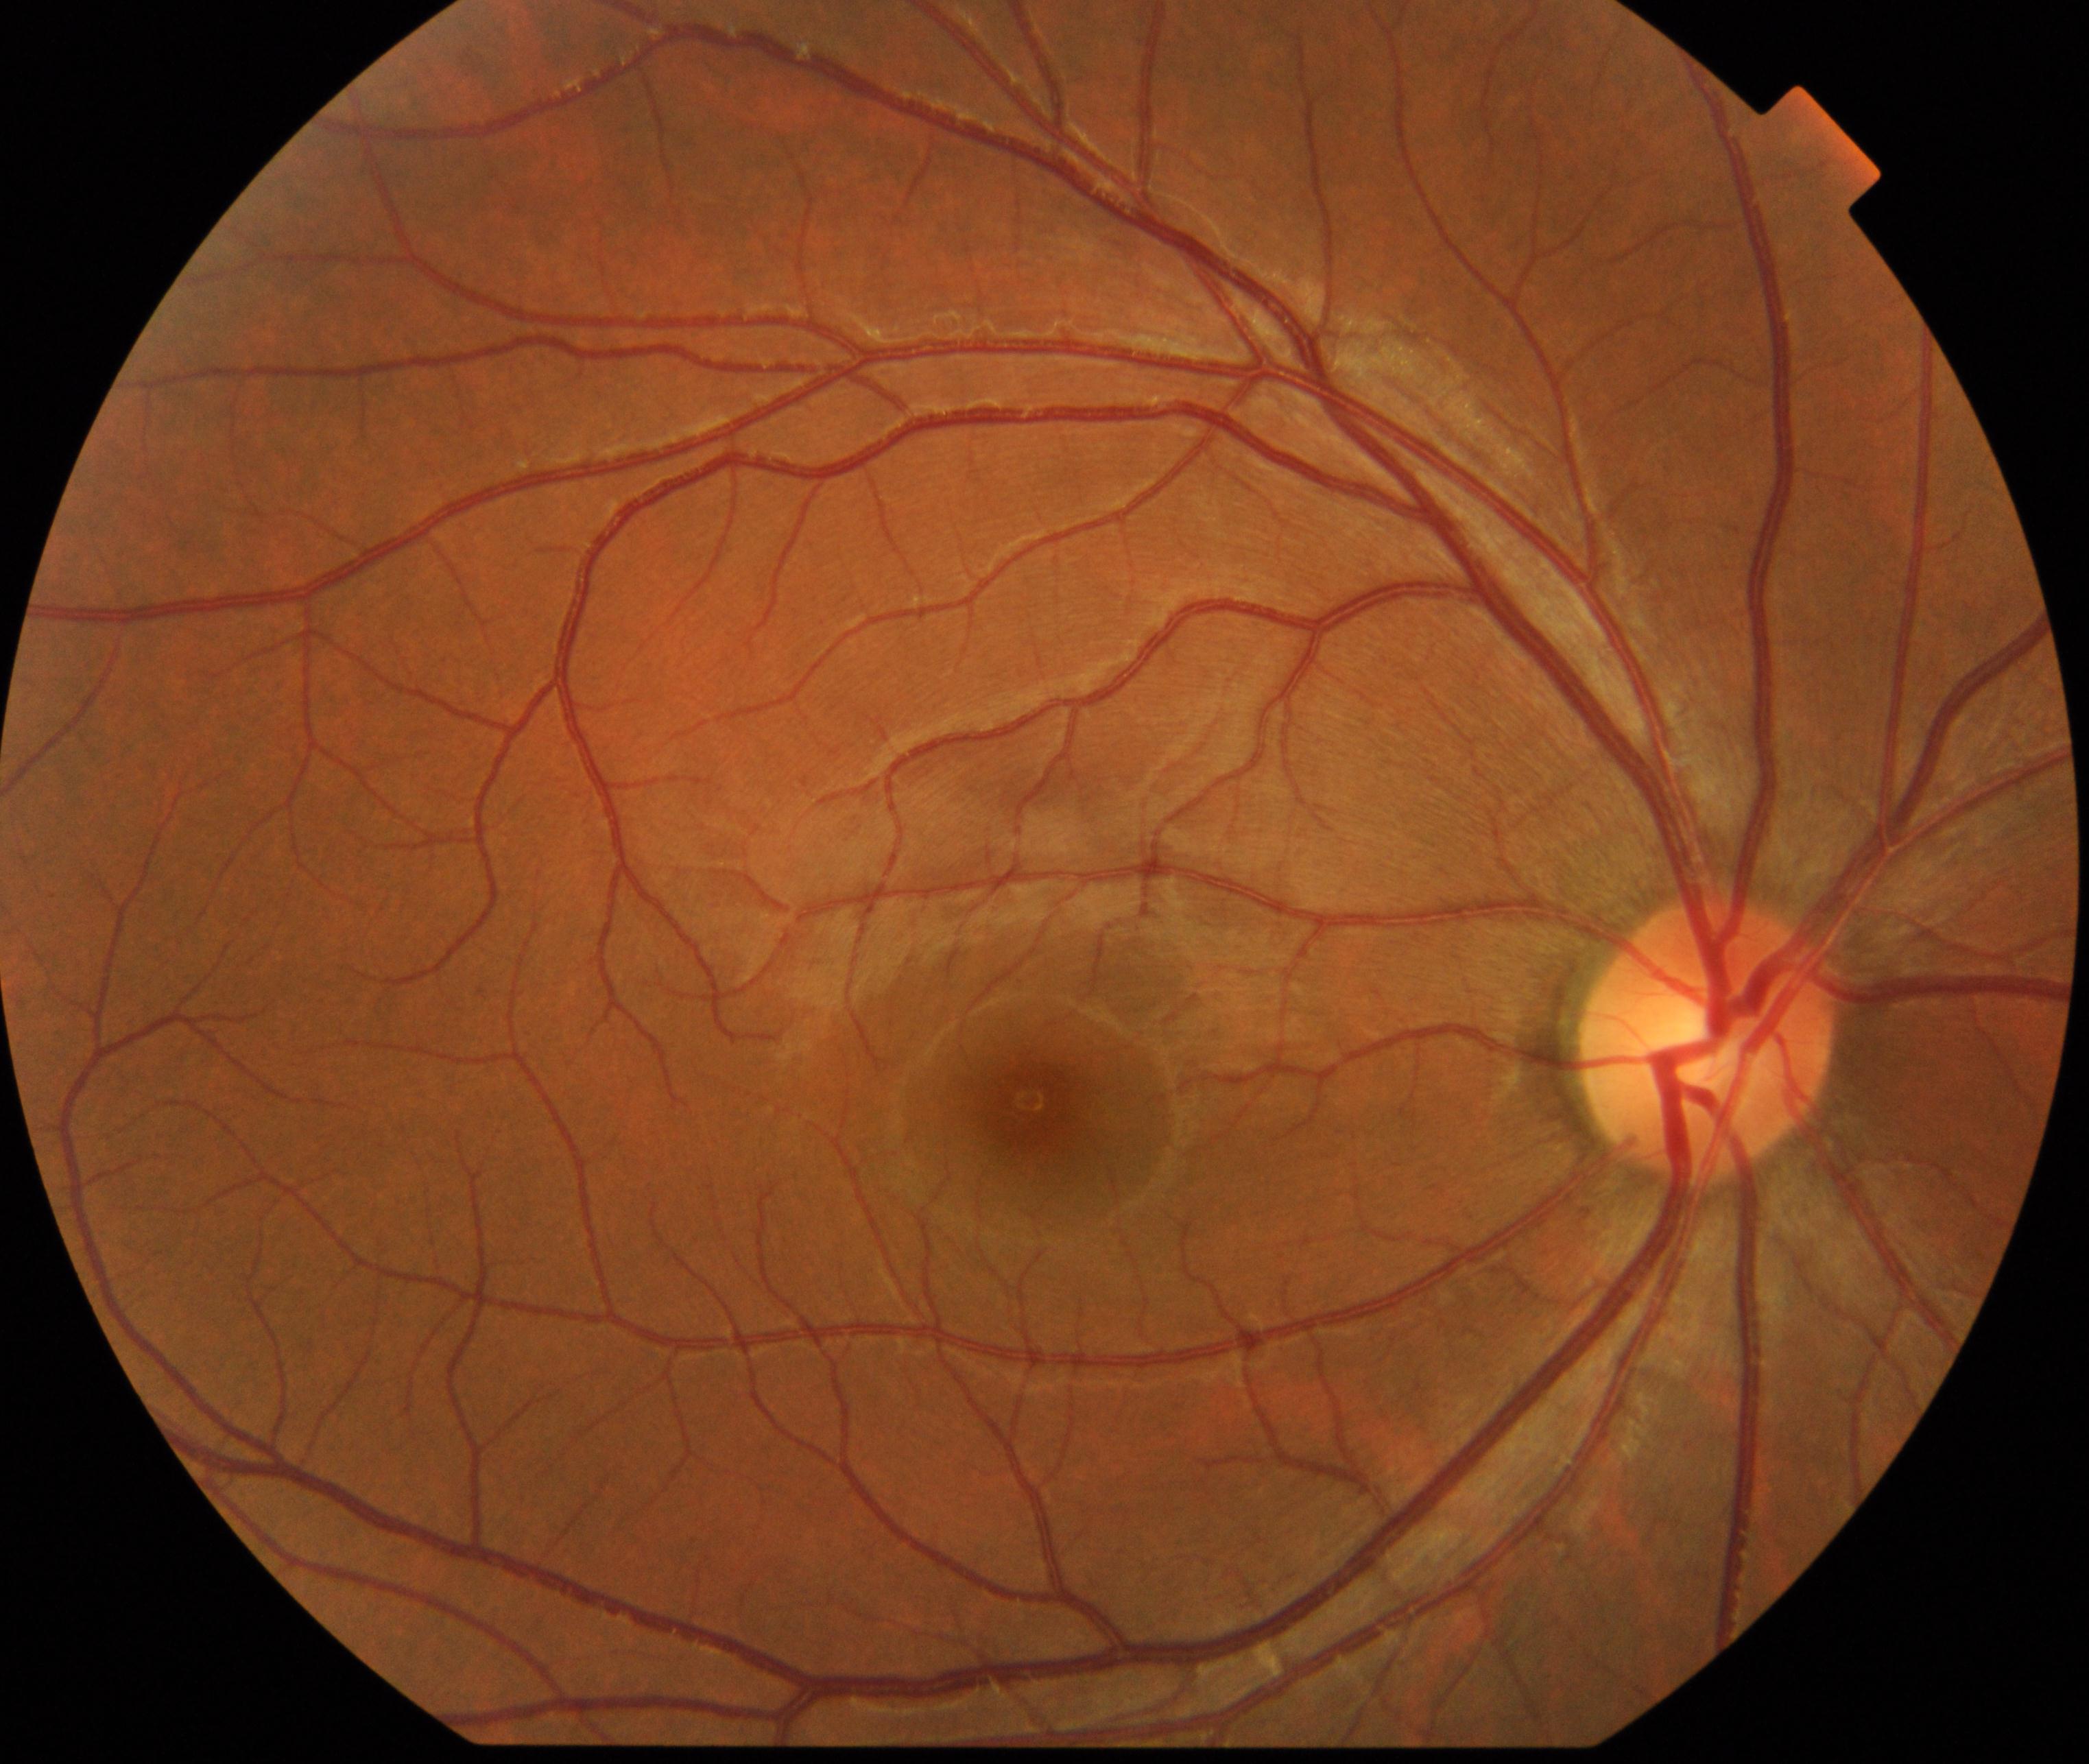

Diagnosis: normal.